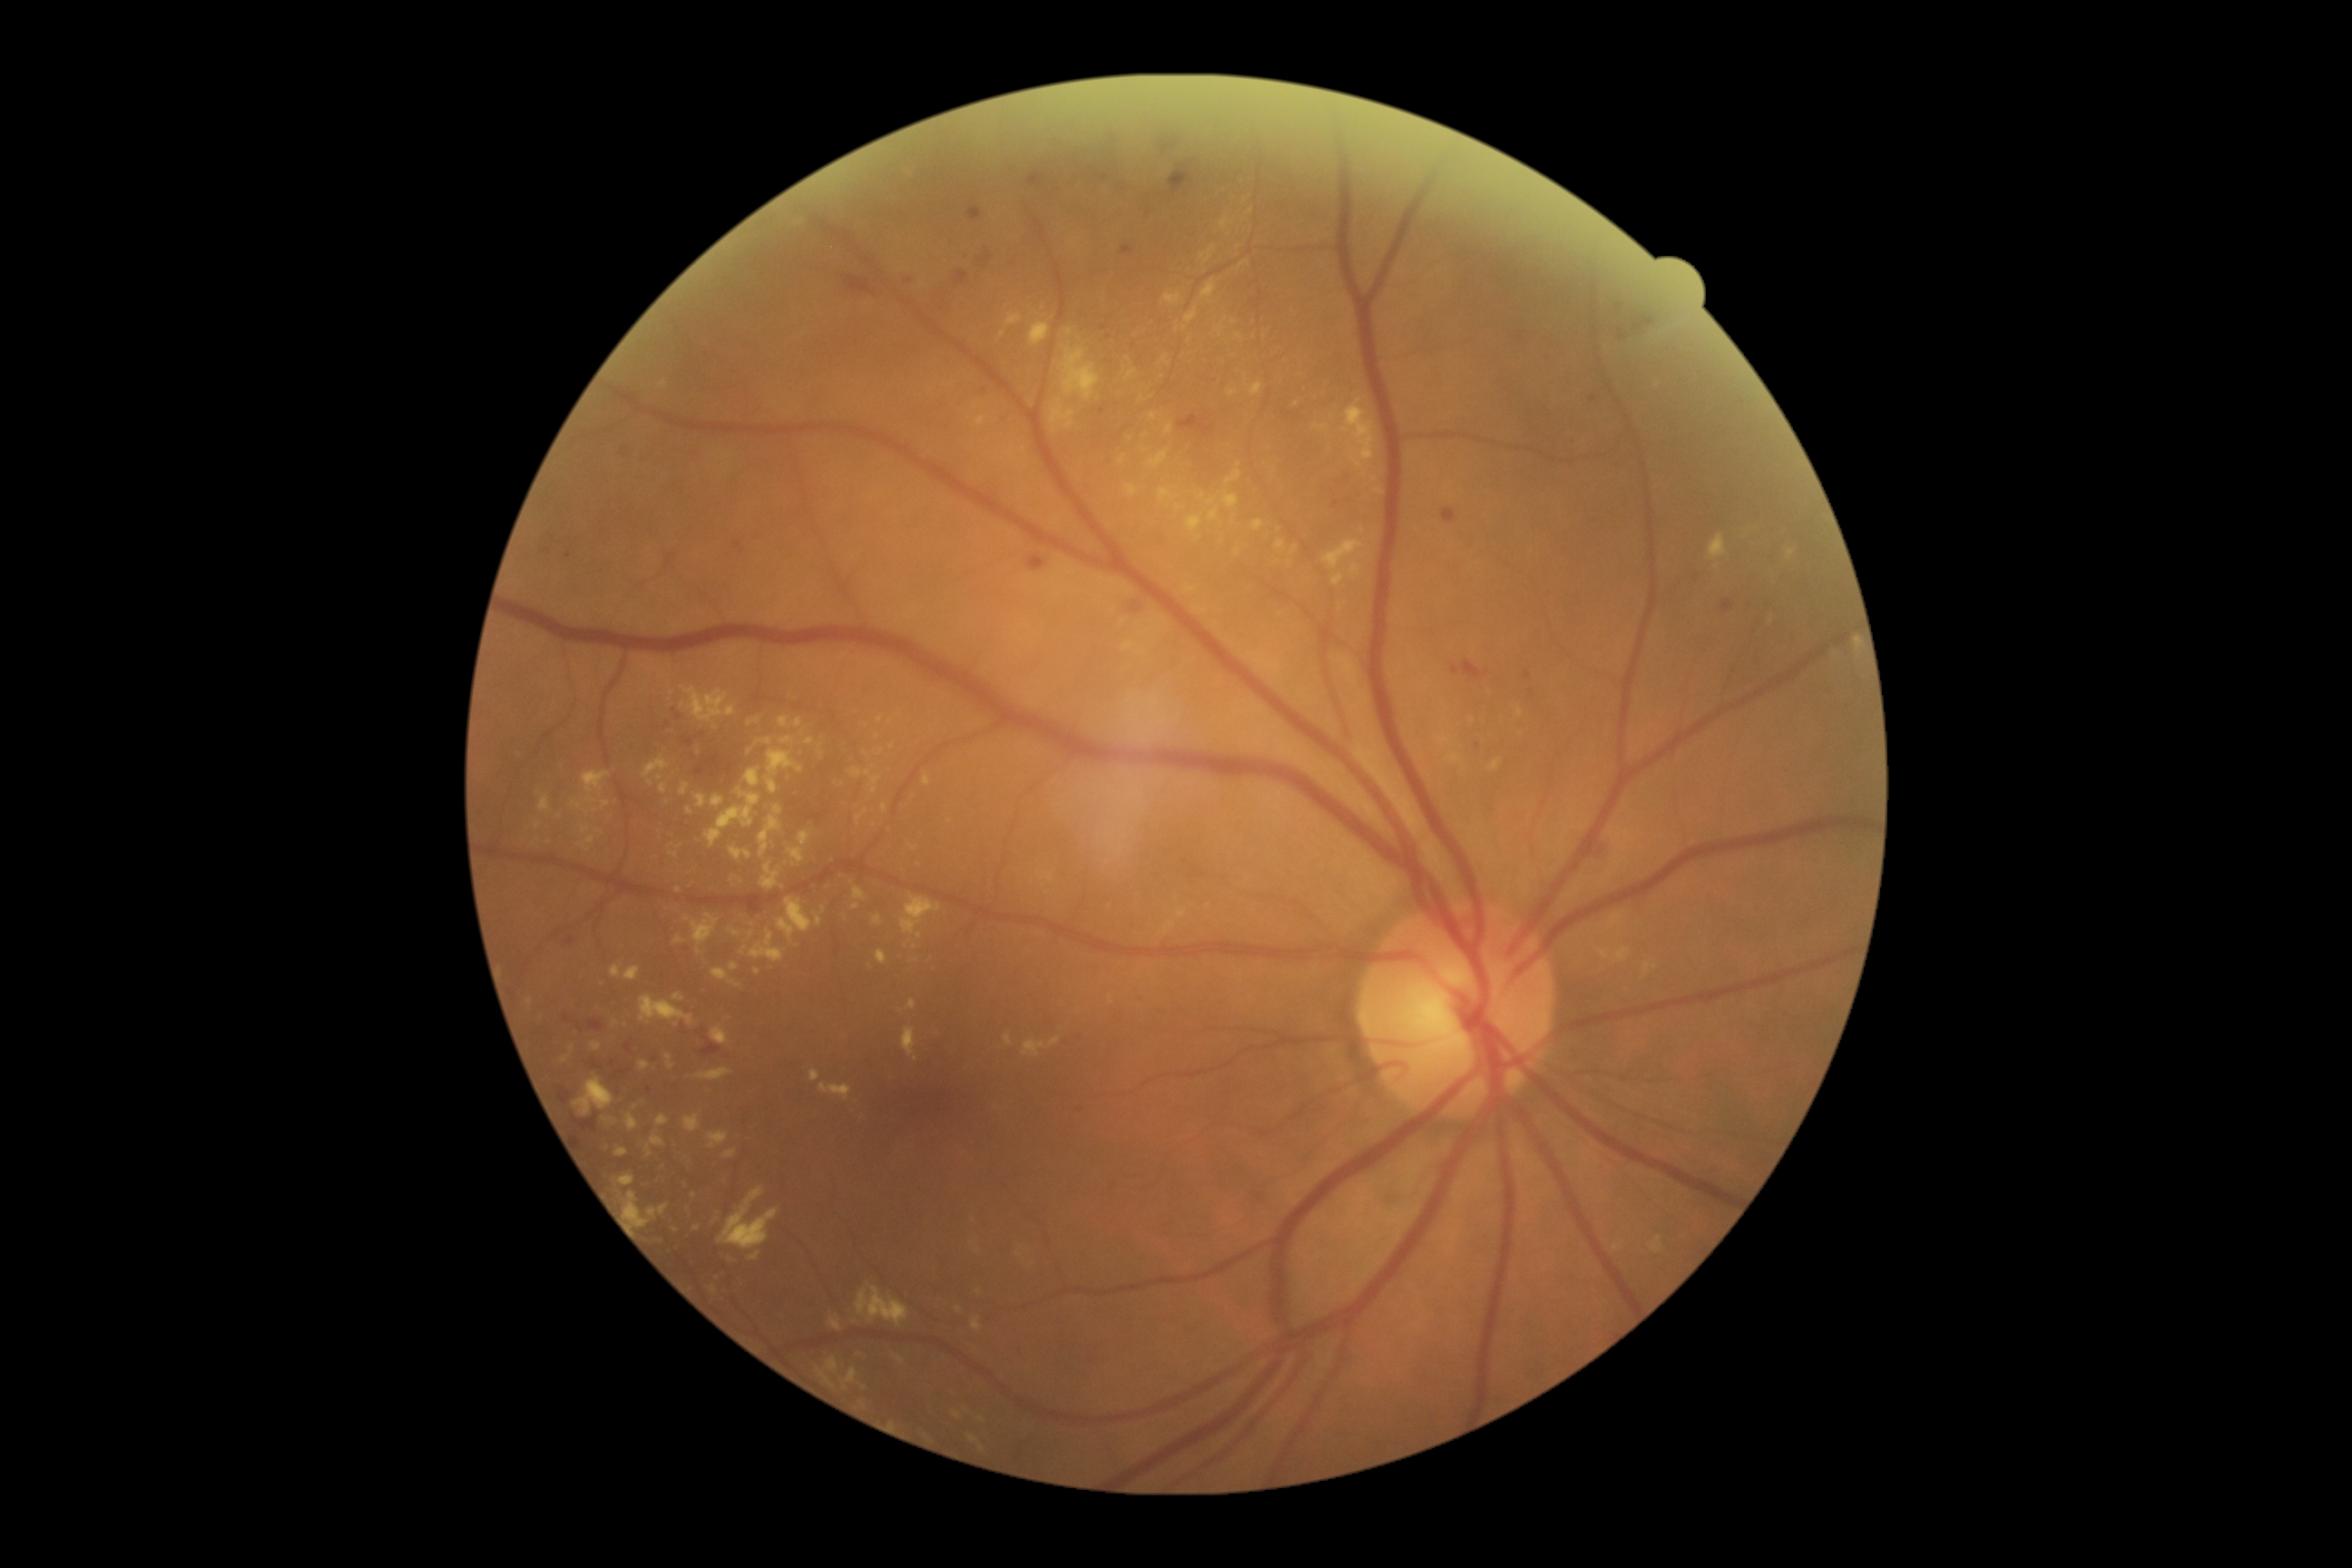

Diabetic retinopathy: 2 — more than just microaneurysms but less than severe NPDR.
Hard exudates include lesions at 977/416/986/427 | 638/1061/651/1072 | 897/1357/906/1366 | 1315/424/1331/431 | 665/1054/676/1070 | 681/687/736/723 | 1651/1237/1663/1253 | 1148/451/1170/469 | 816/1357/839/1389 | 669/852/678/859 | 819/752/825/760 | 625/1115/640/1132.
Additional small hard exudates near 906/946 | 1129/359 | 1369/277 | 752/934 | 615/1025 | 957/1414.